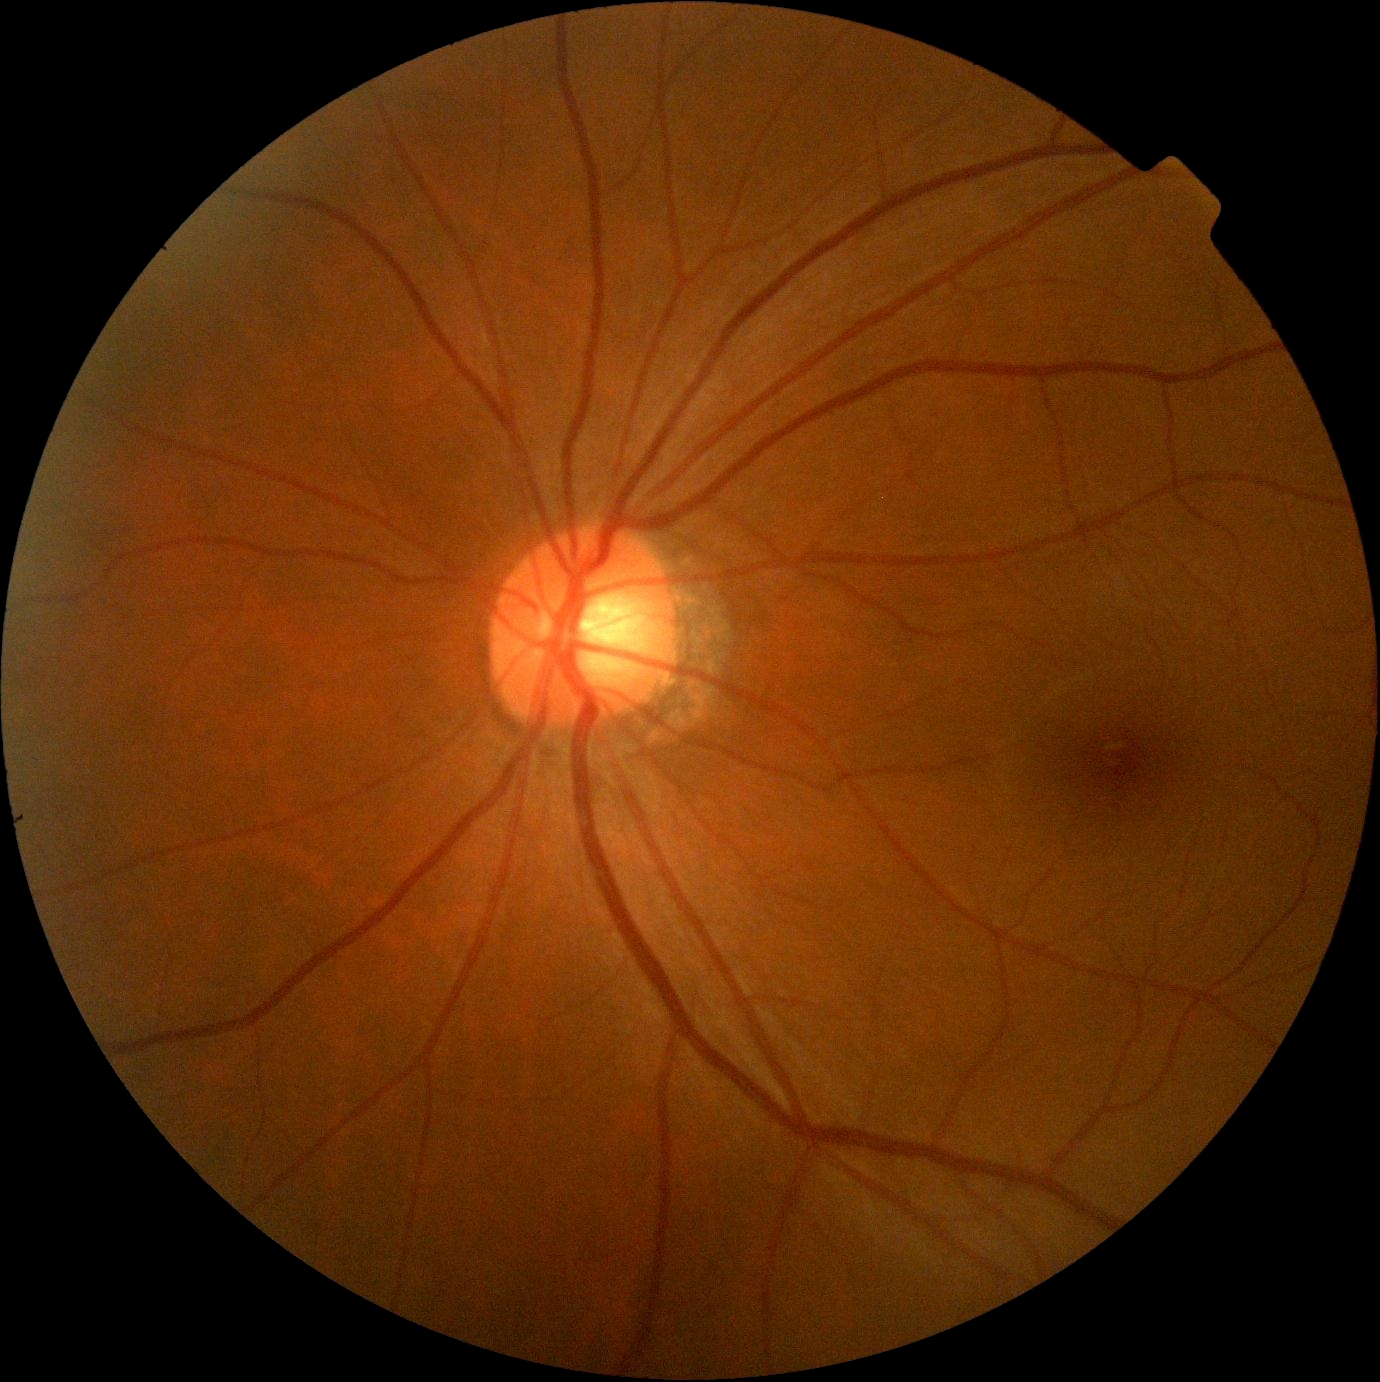
DR is grade 0 (no apparent retinopathy).